Ultra-widefield fundus mosaic, 1924x1556px:
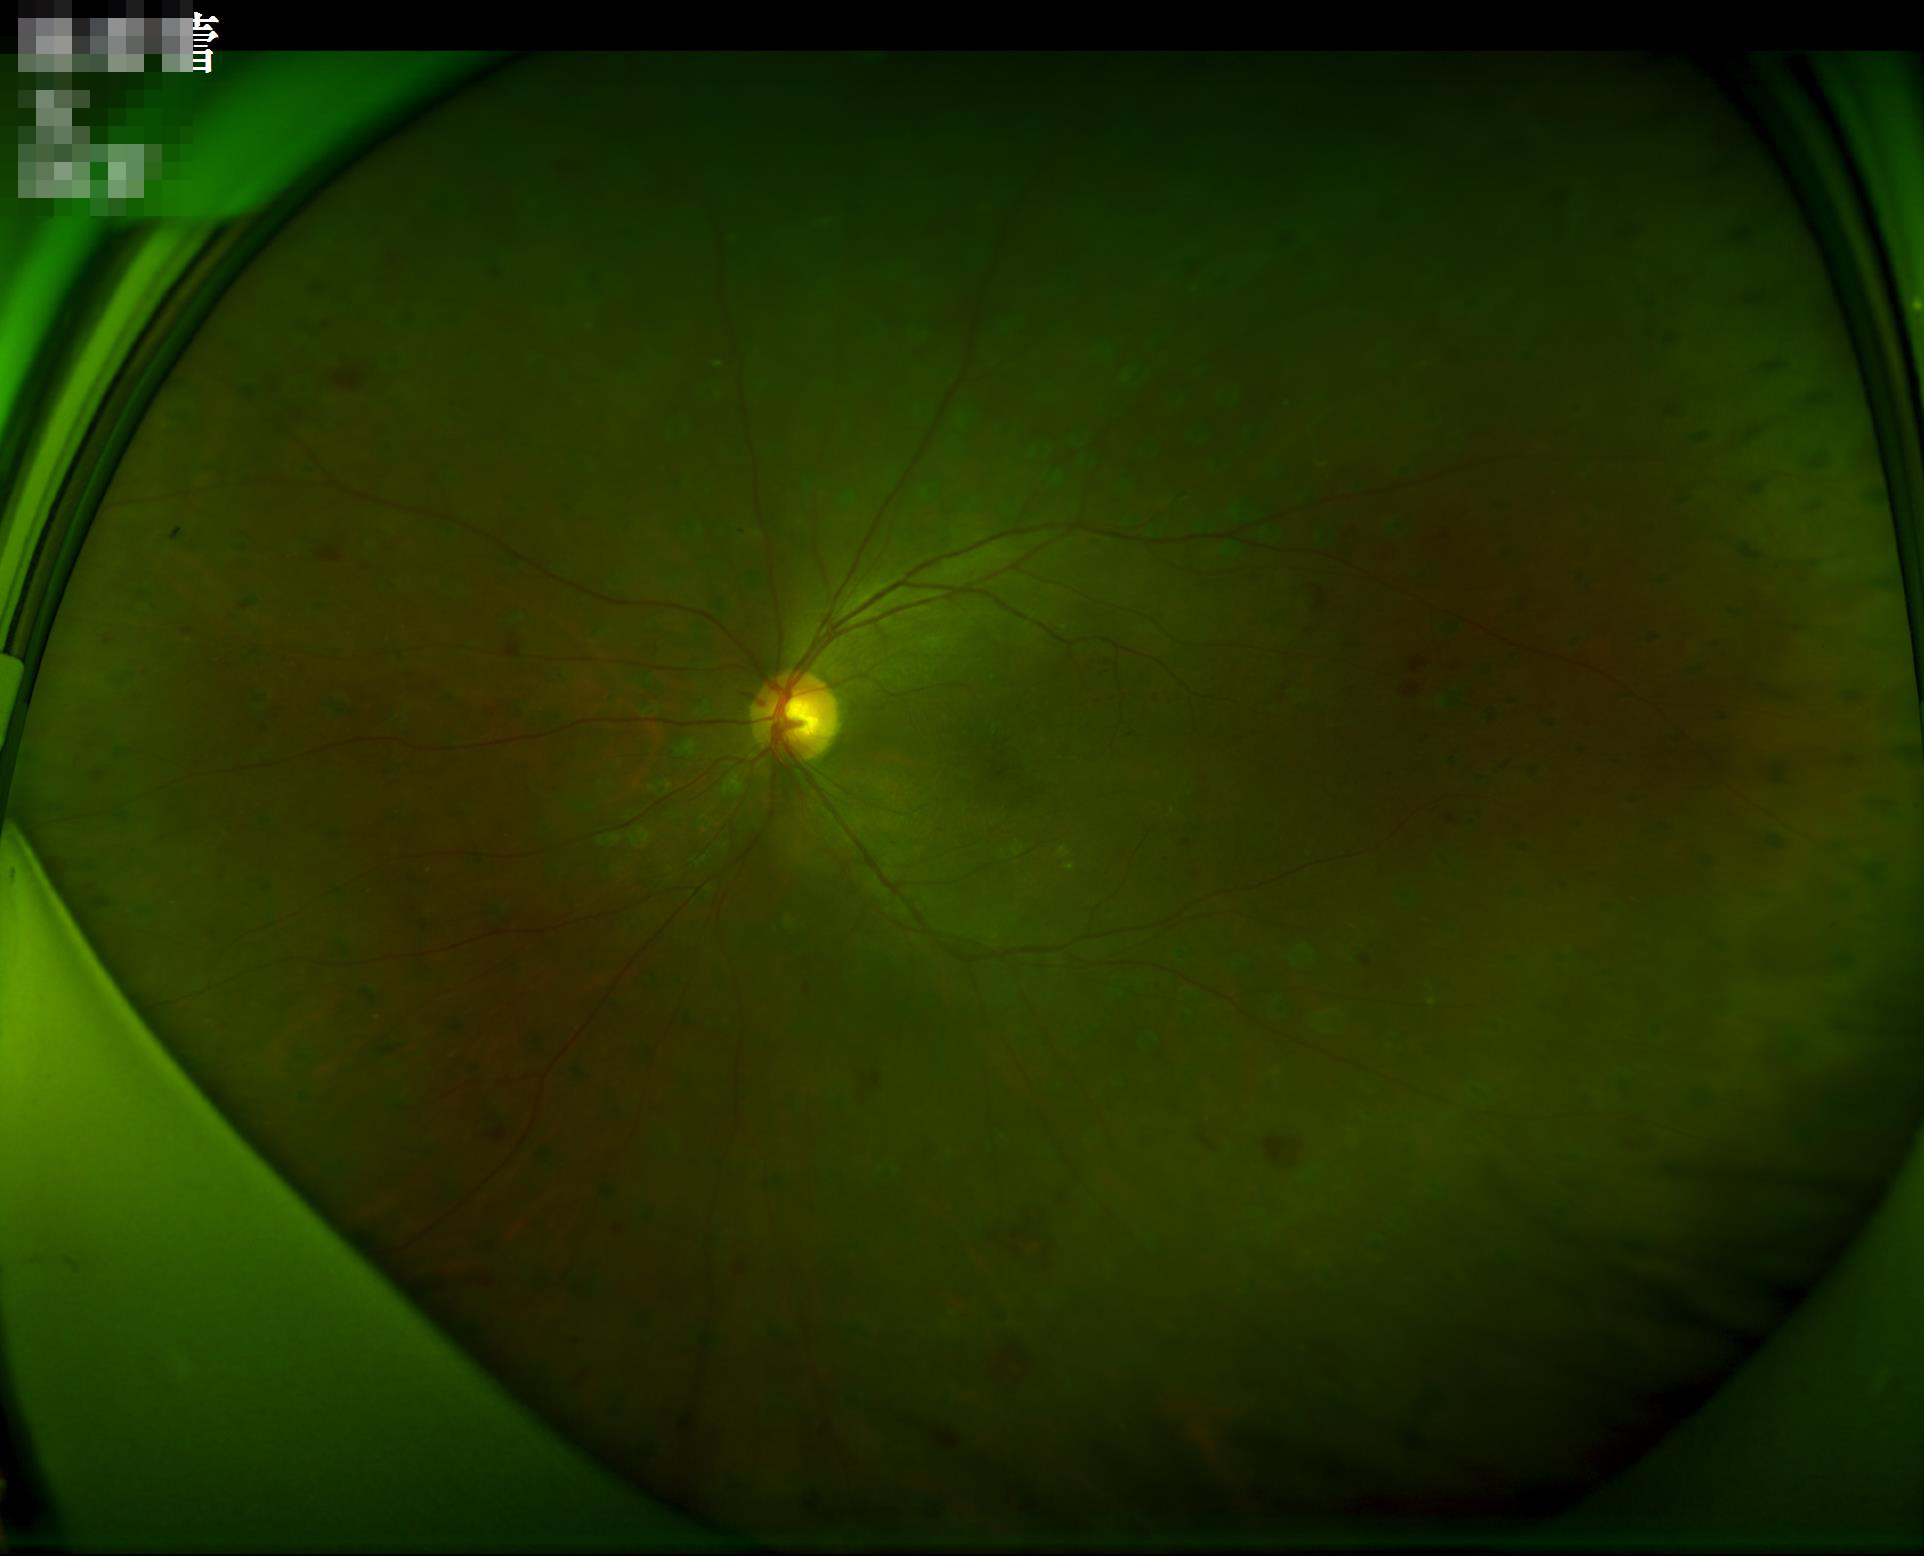
Image quality is adequate for diagnostic use. No noticeable blur. Adequate contrast for distinguishing structures.